50° FOV · 1932 by 1932 pixels · captured on a Topcon TRC-NW8 fundus camera — 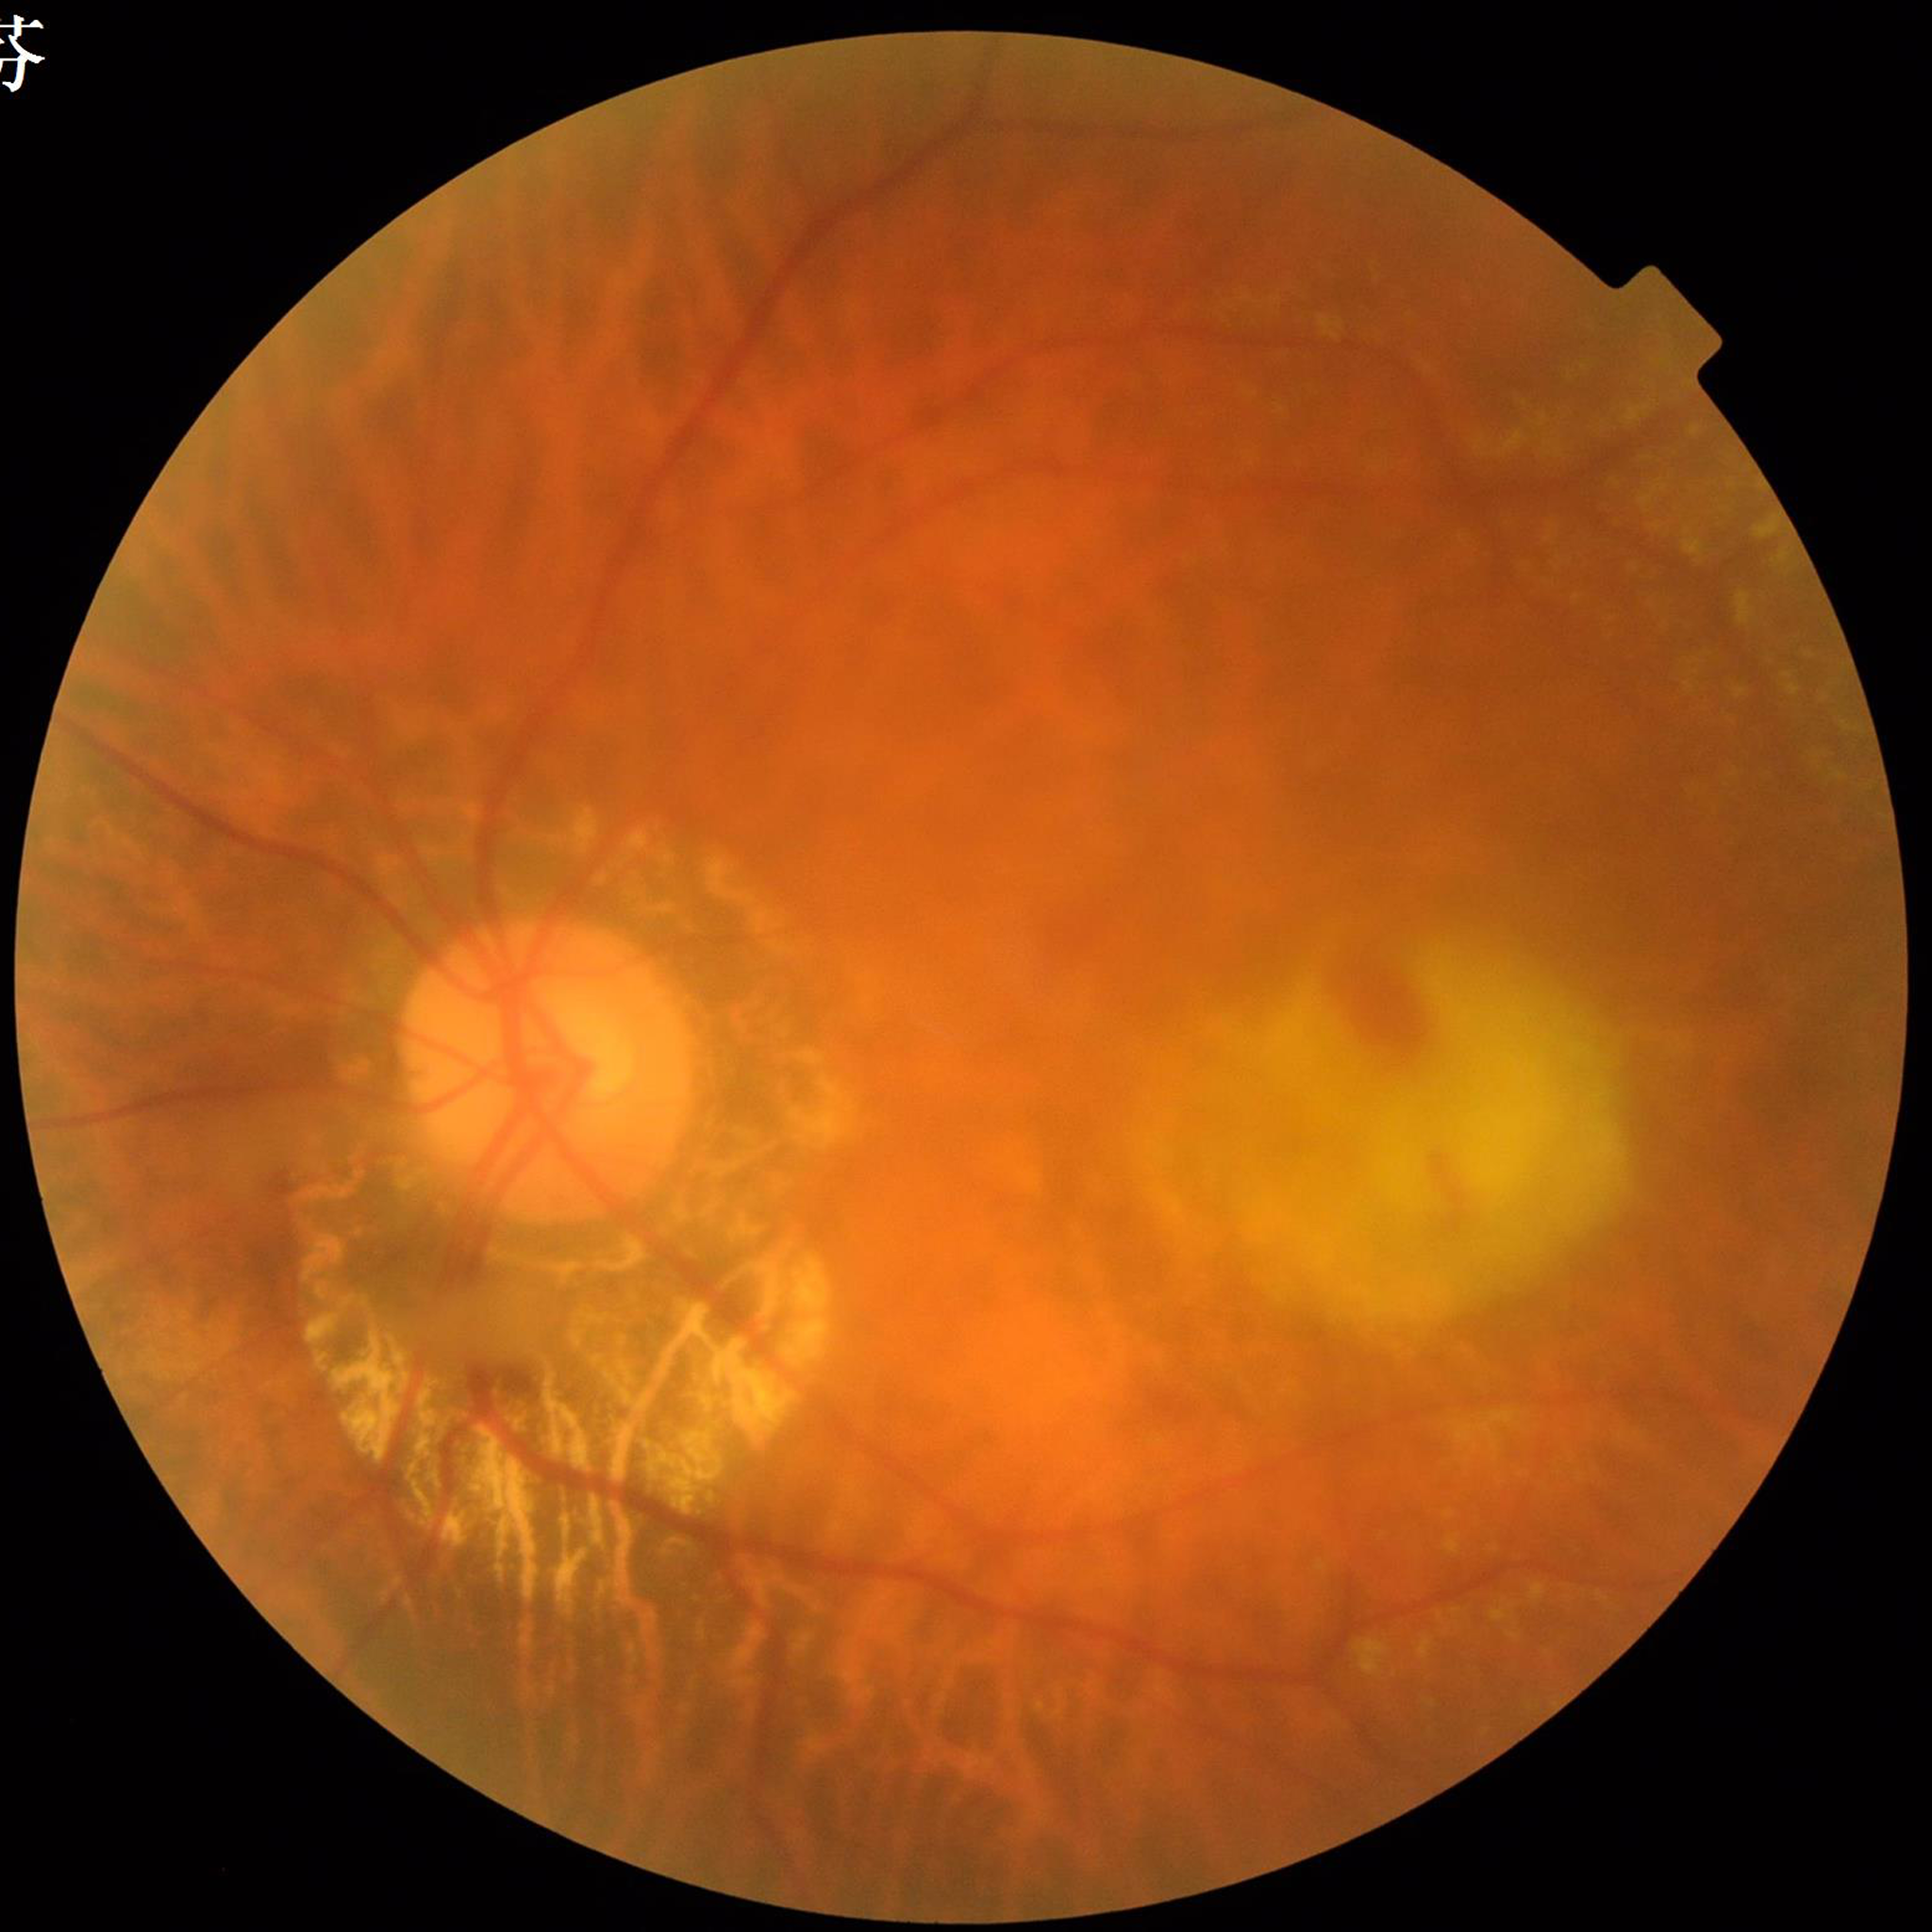 From a patient with age-related macular degeneration.